Nidek AFC-330, non-mydriatic fundus camera
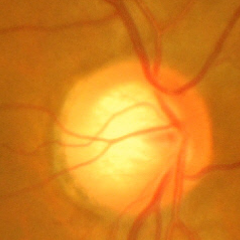
Optic nerve head appearance consistent with advanced-stage glaucoma.